Wide-field fundus photograph of an infant · 130° field of view (Clarity RetCam 3) — 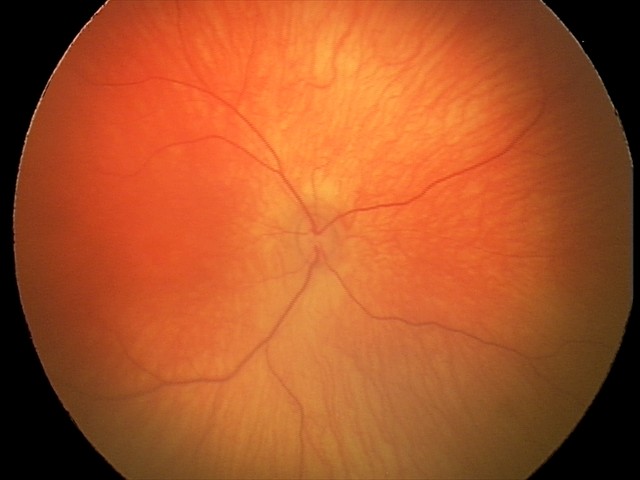

Screening: physiological appearance with no retinal pathology.